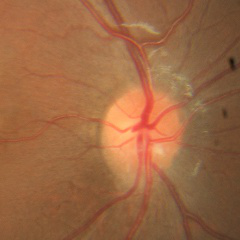

Q: Glaucoma assessment?
A: No glaucomatous optic neuropathy.